45-degree field of view — 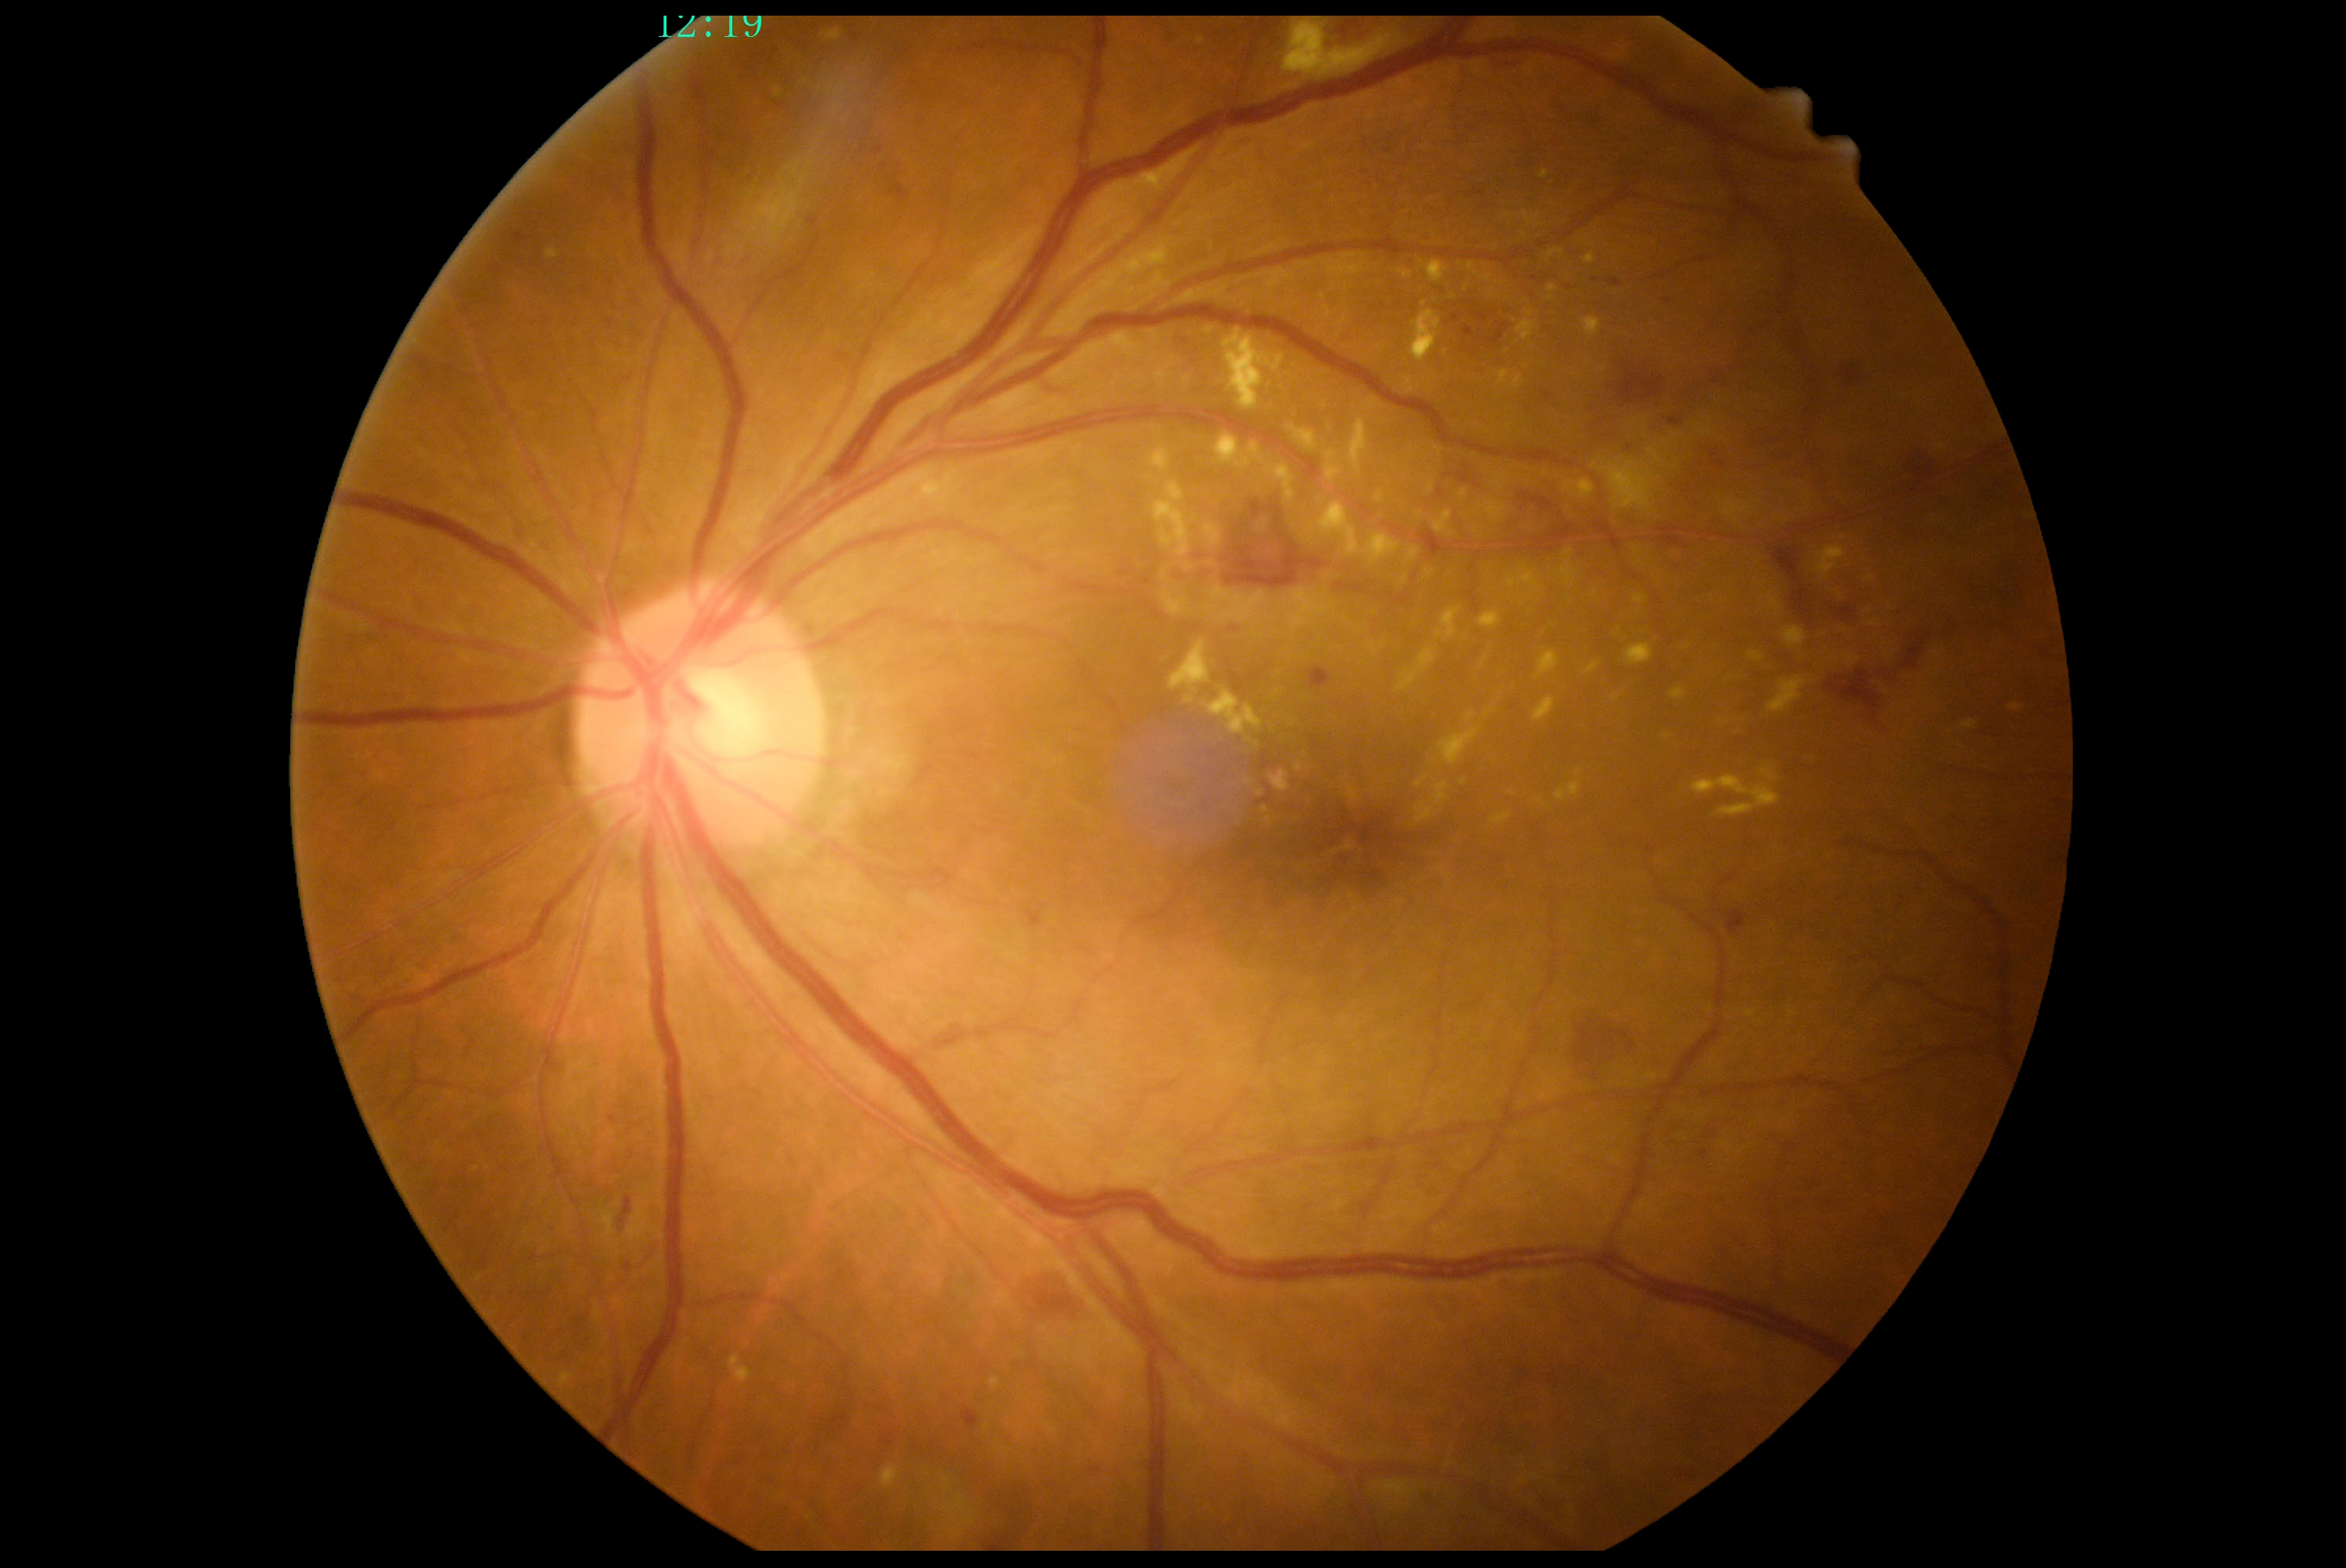 Retinopathy is 2.